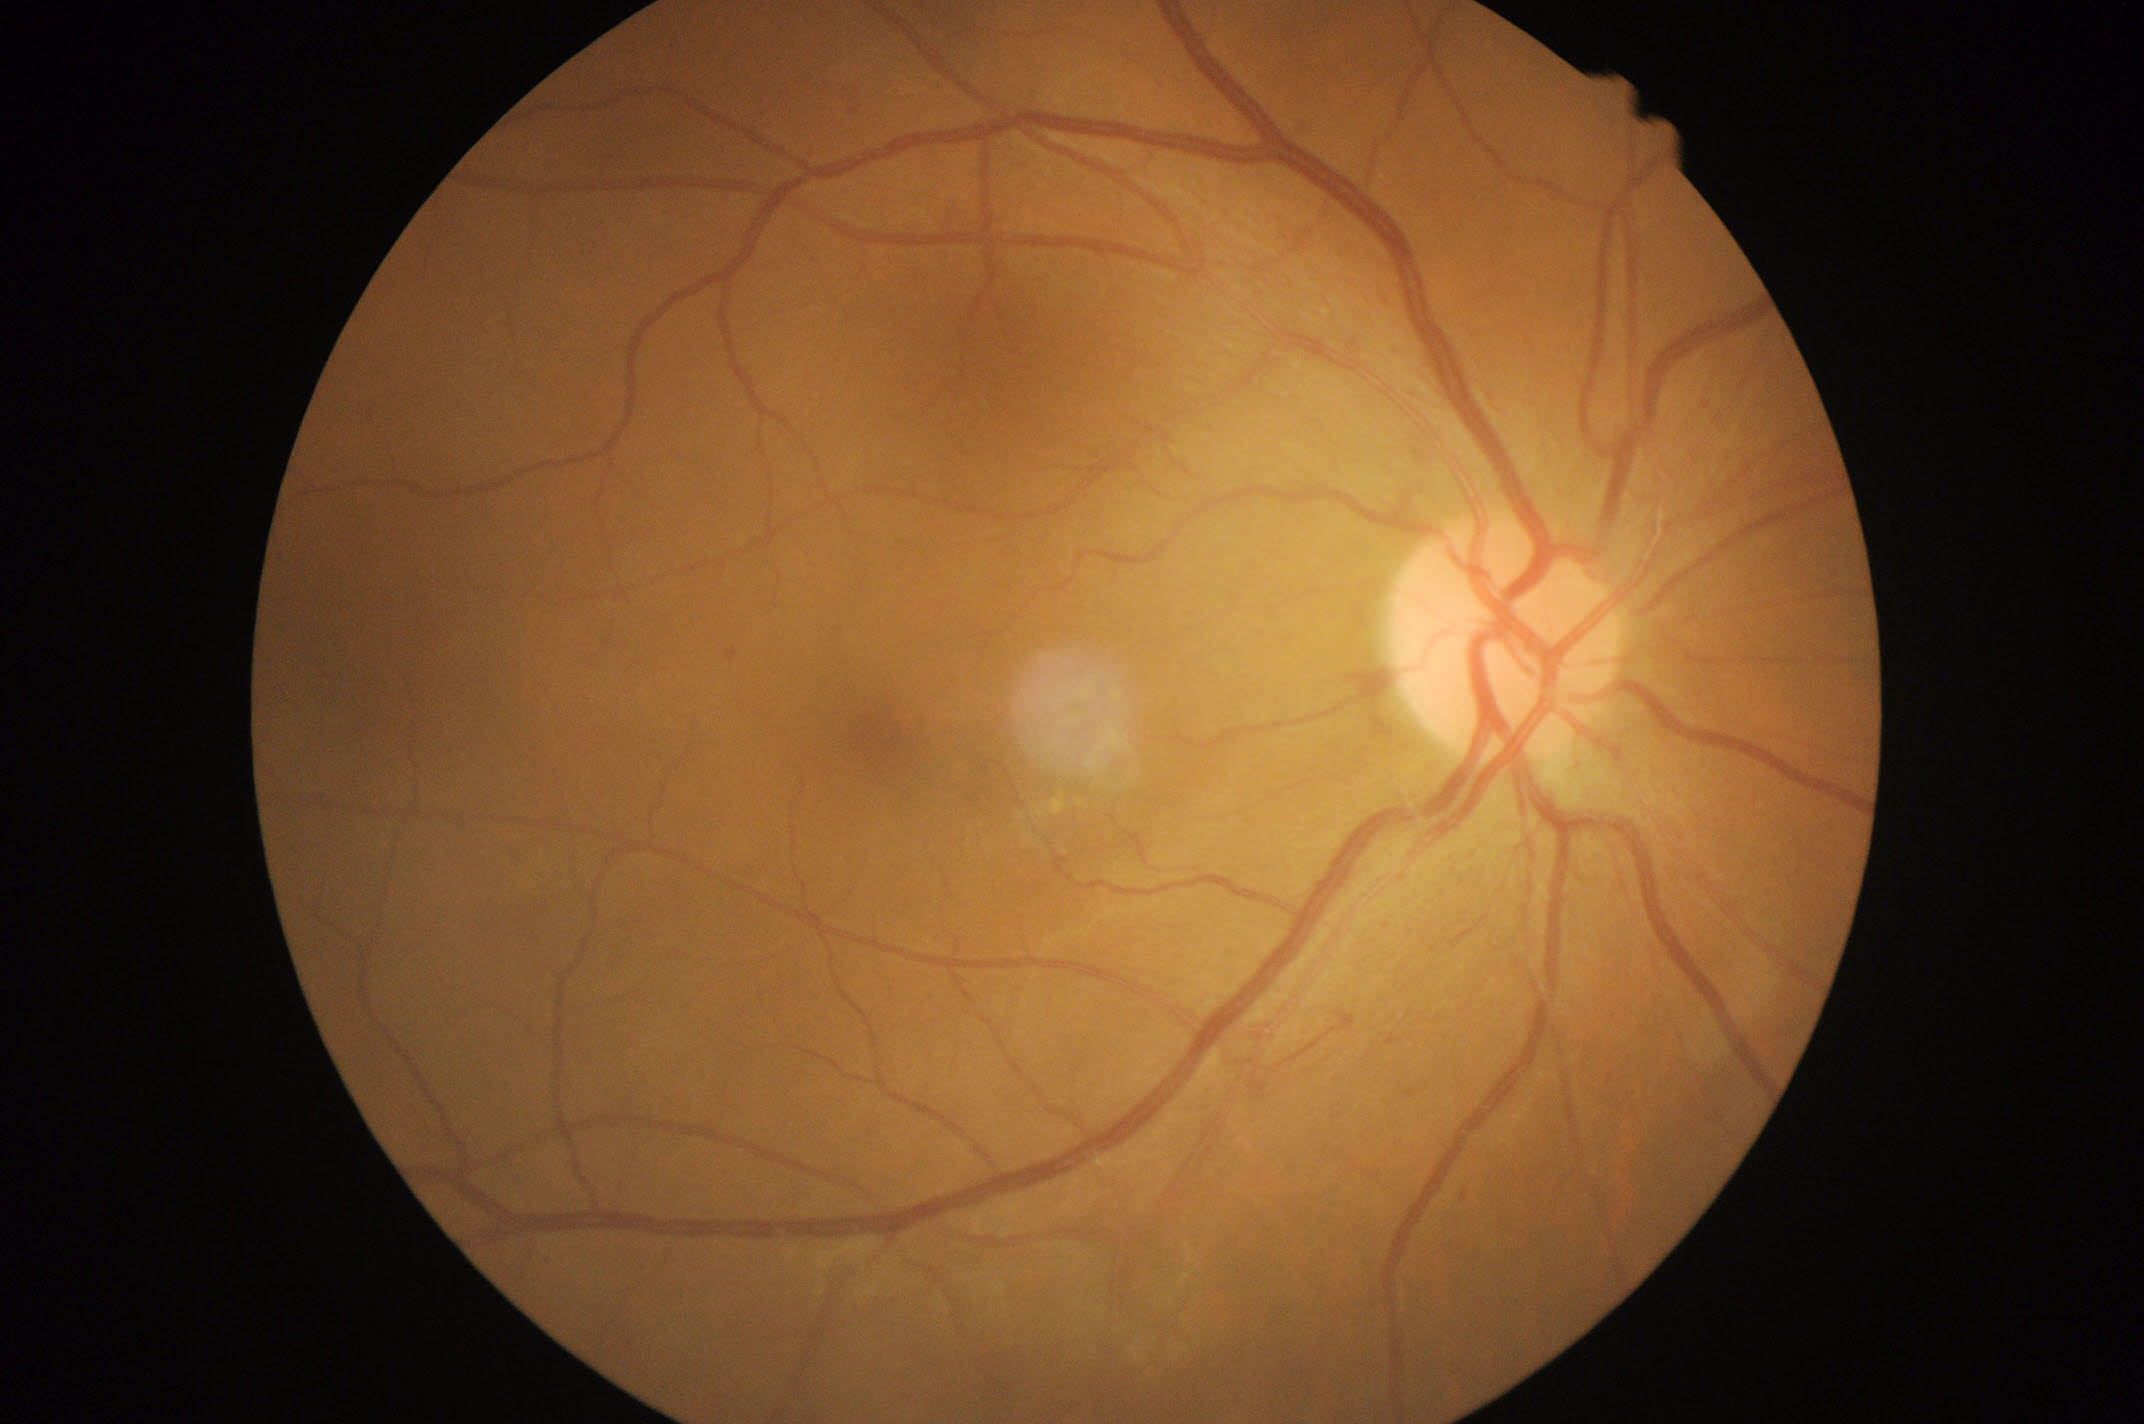 Disease class: non-proliferative diabetic retinopathy.
DR grade: 1.